Posterior pole photograph, Davis DR grading: 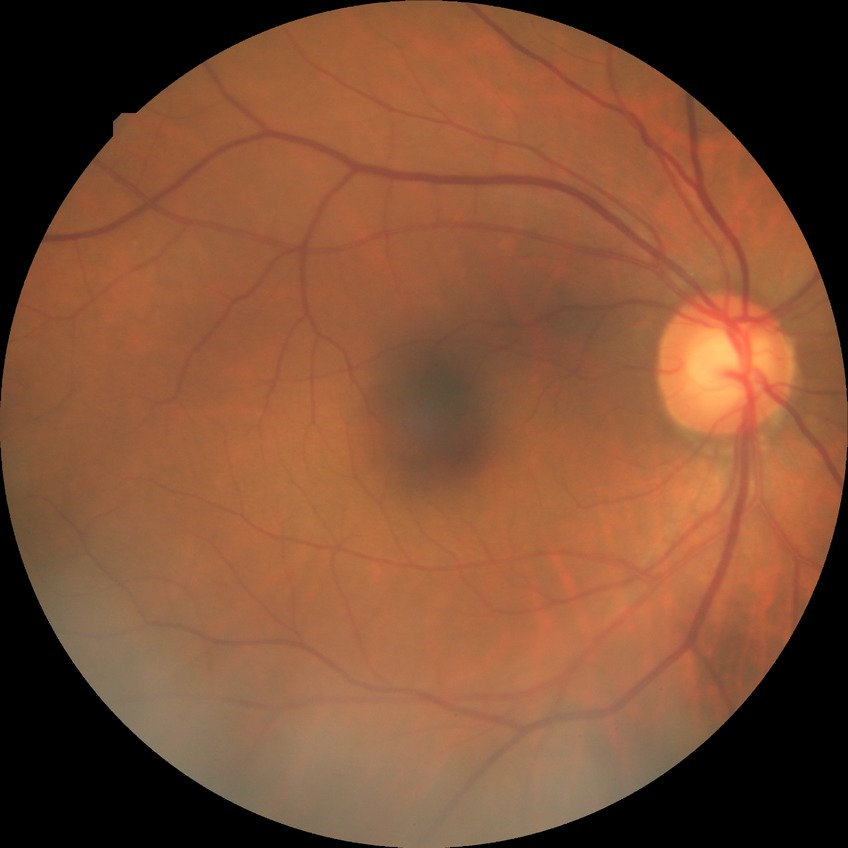

{
  "davis_grade": "no diabetic retinopathy"
}